Camera: Nidek AFC-330, 240x240.
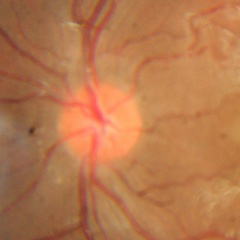
Glaucoma status = no glaucomatous optic neuropathy.